2048 by 1536 pixels.
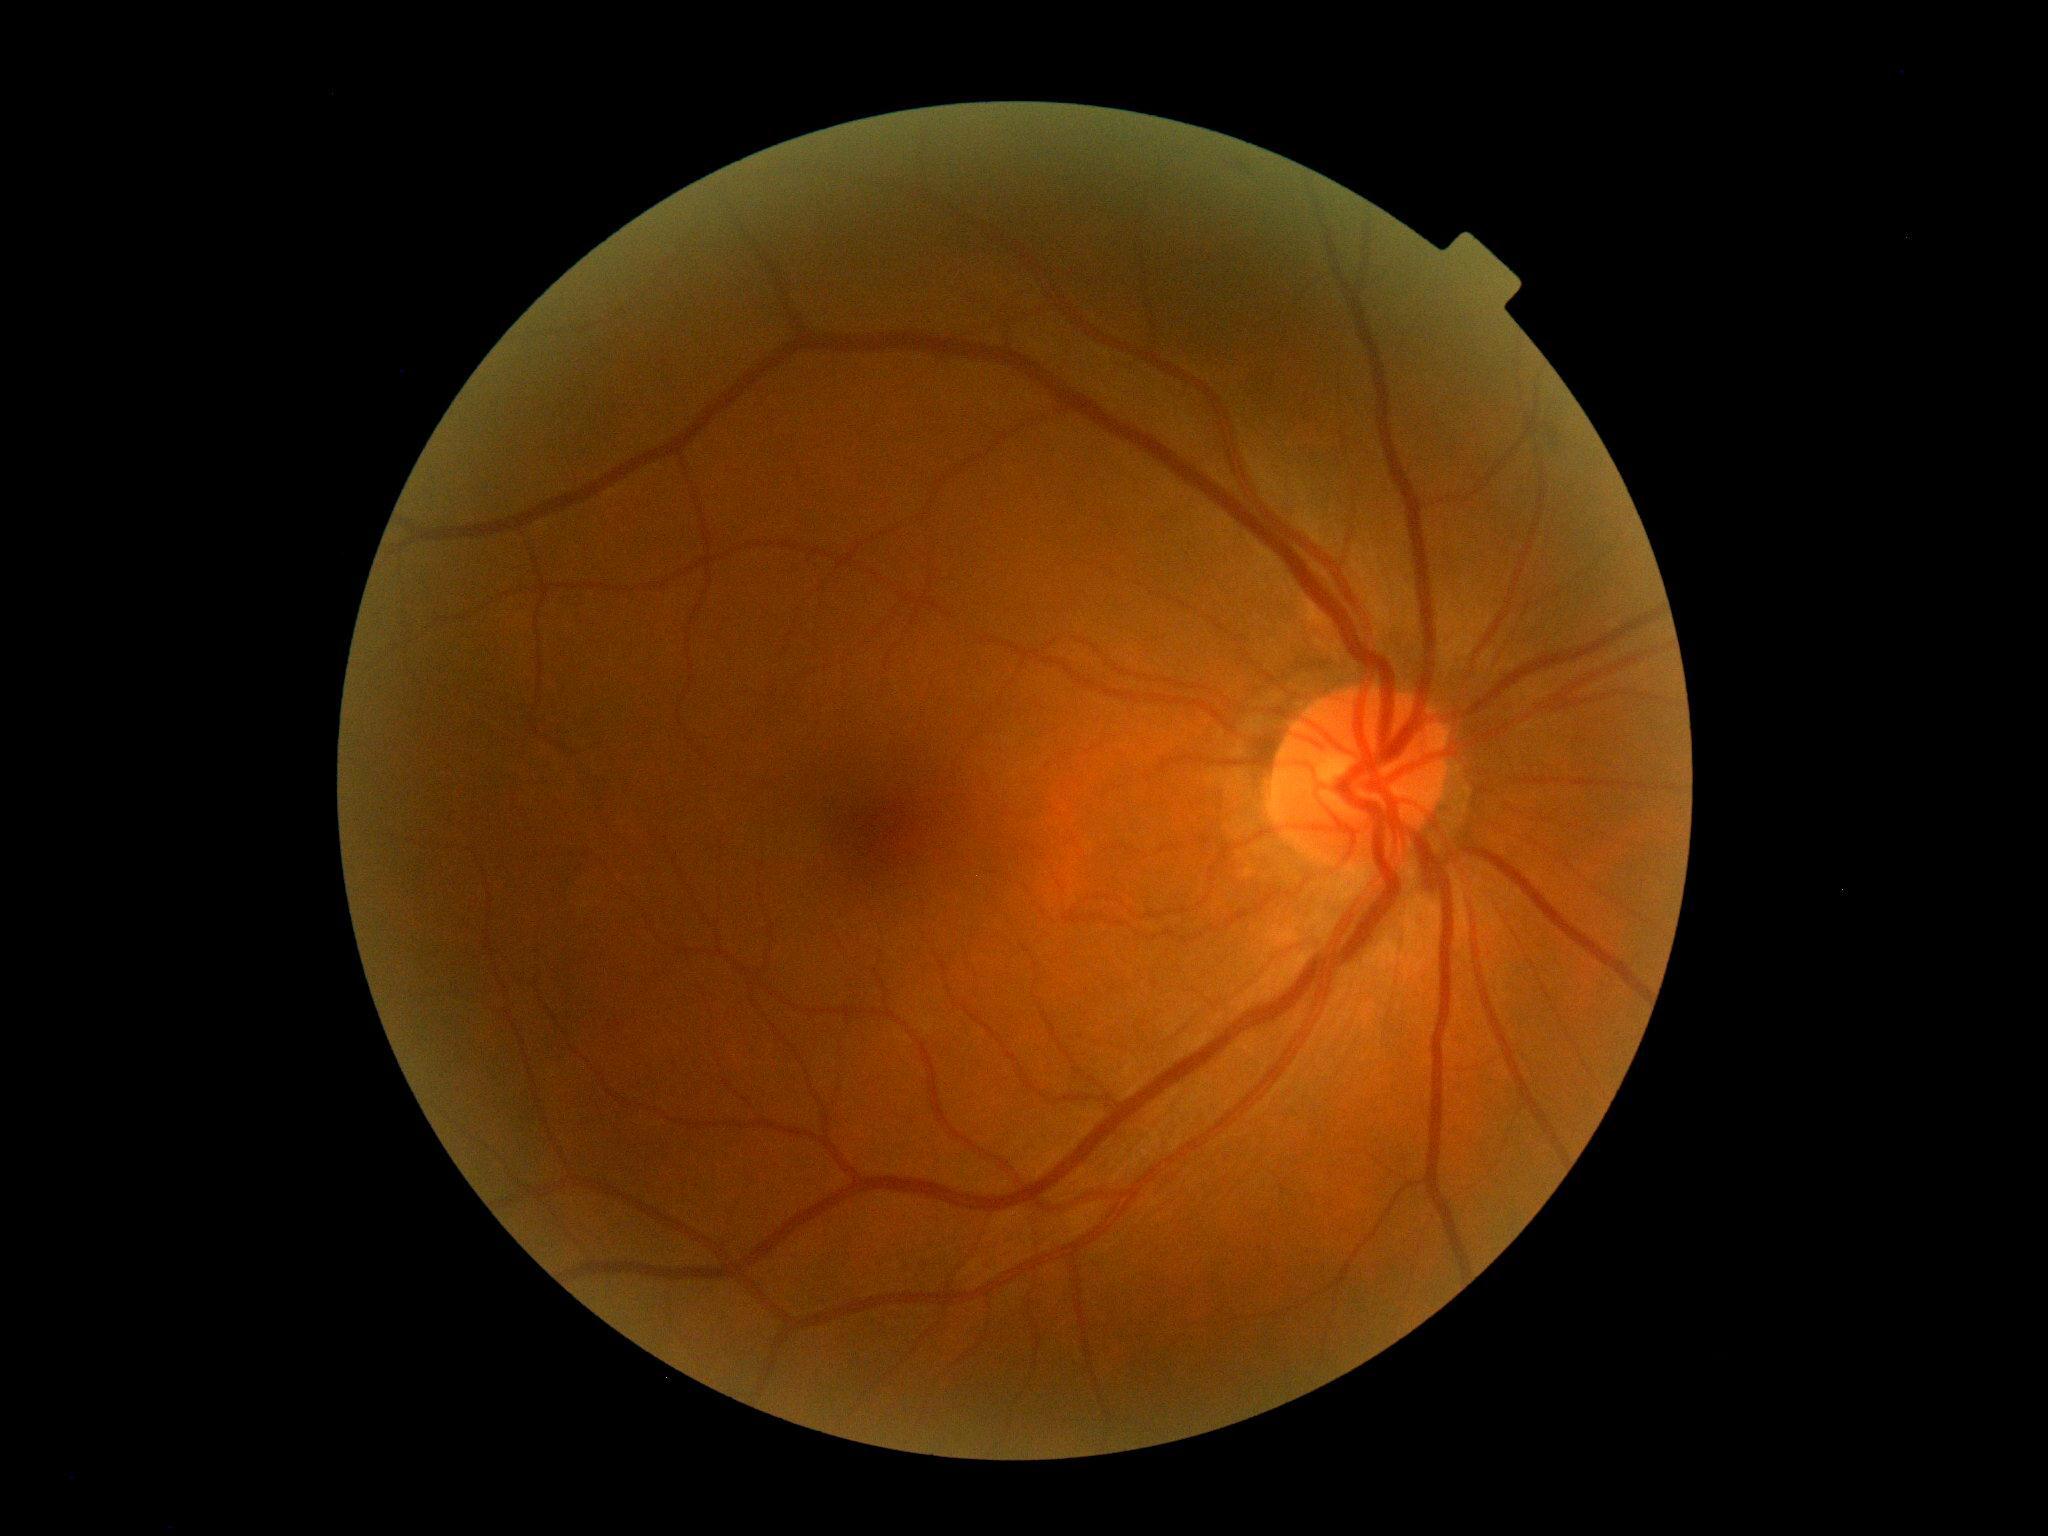

Annotations:
– diabetic retinopathy (DR) — grade 0 (no apparent retinopathy)
– DR impression — no DR findings